Natus RetCam Envision, 130° FOV. Wide-field fundus image from infant ROP screening: 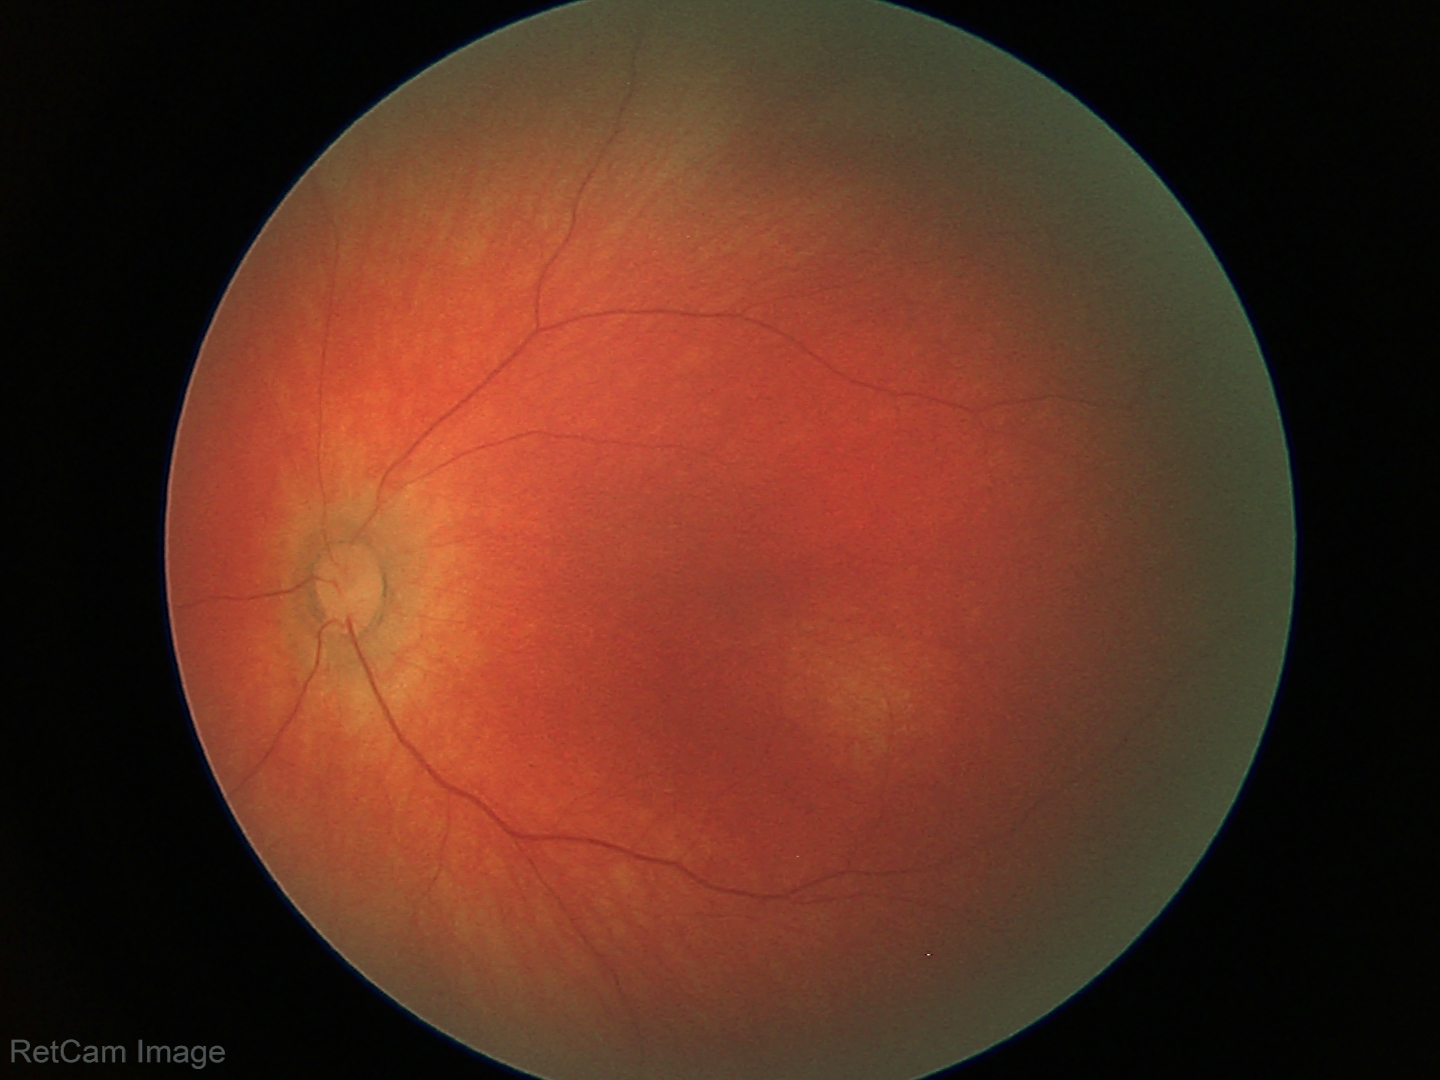
Physiological retinal appearance for postconceptual age.